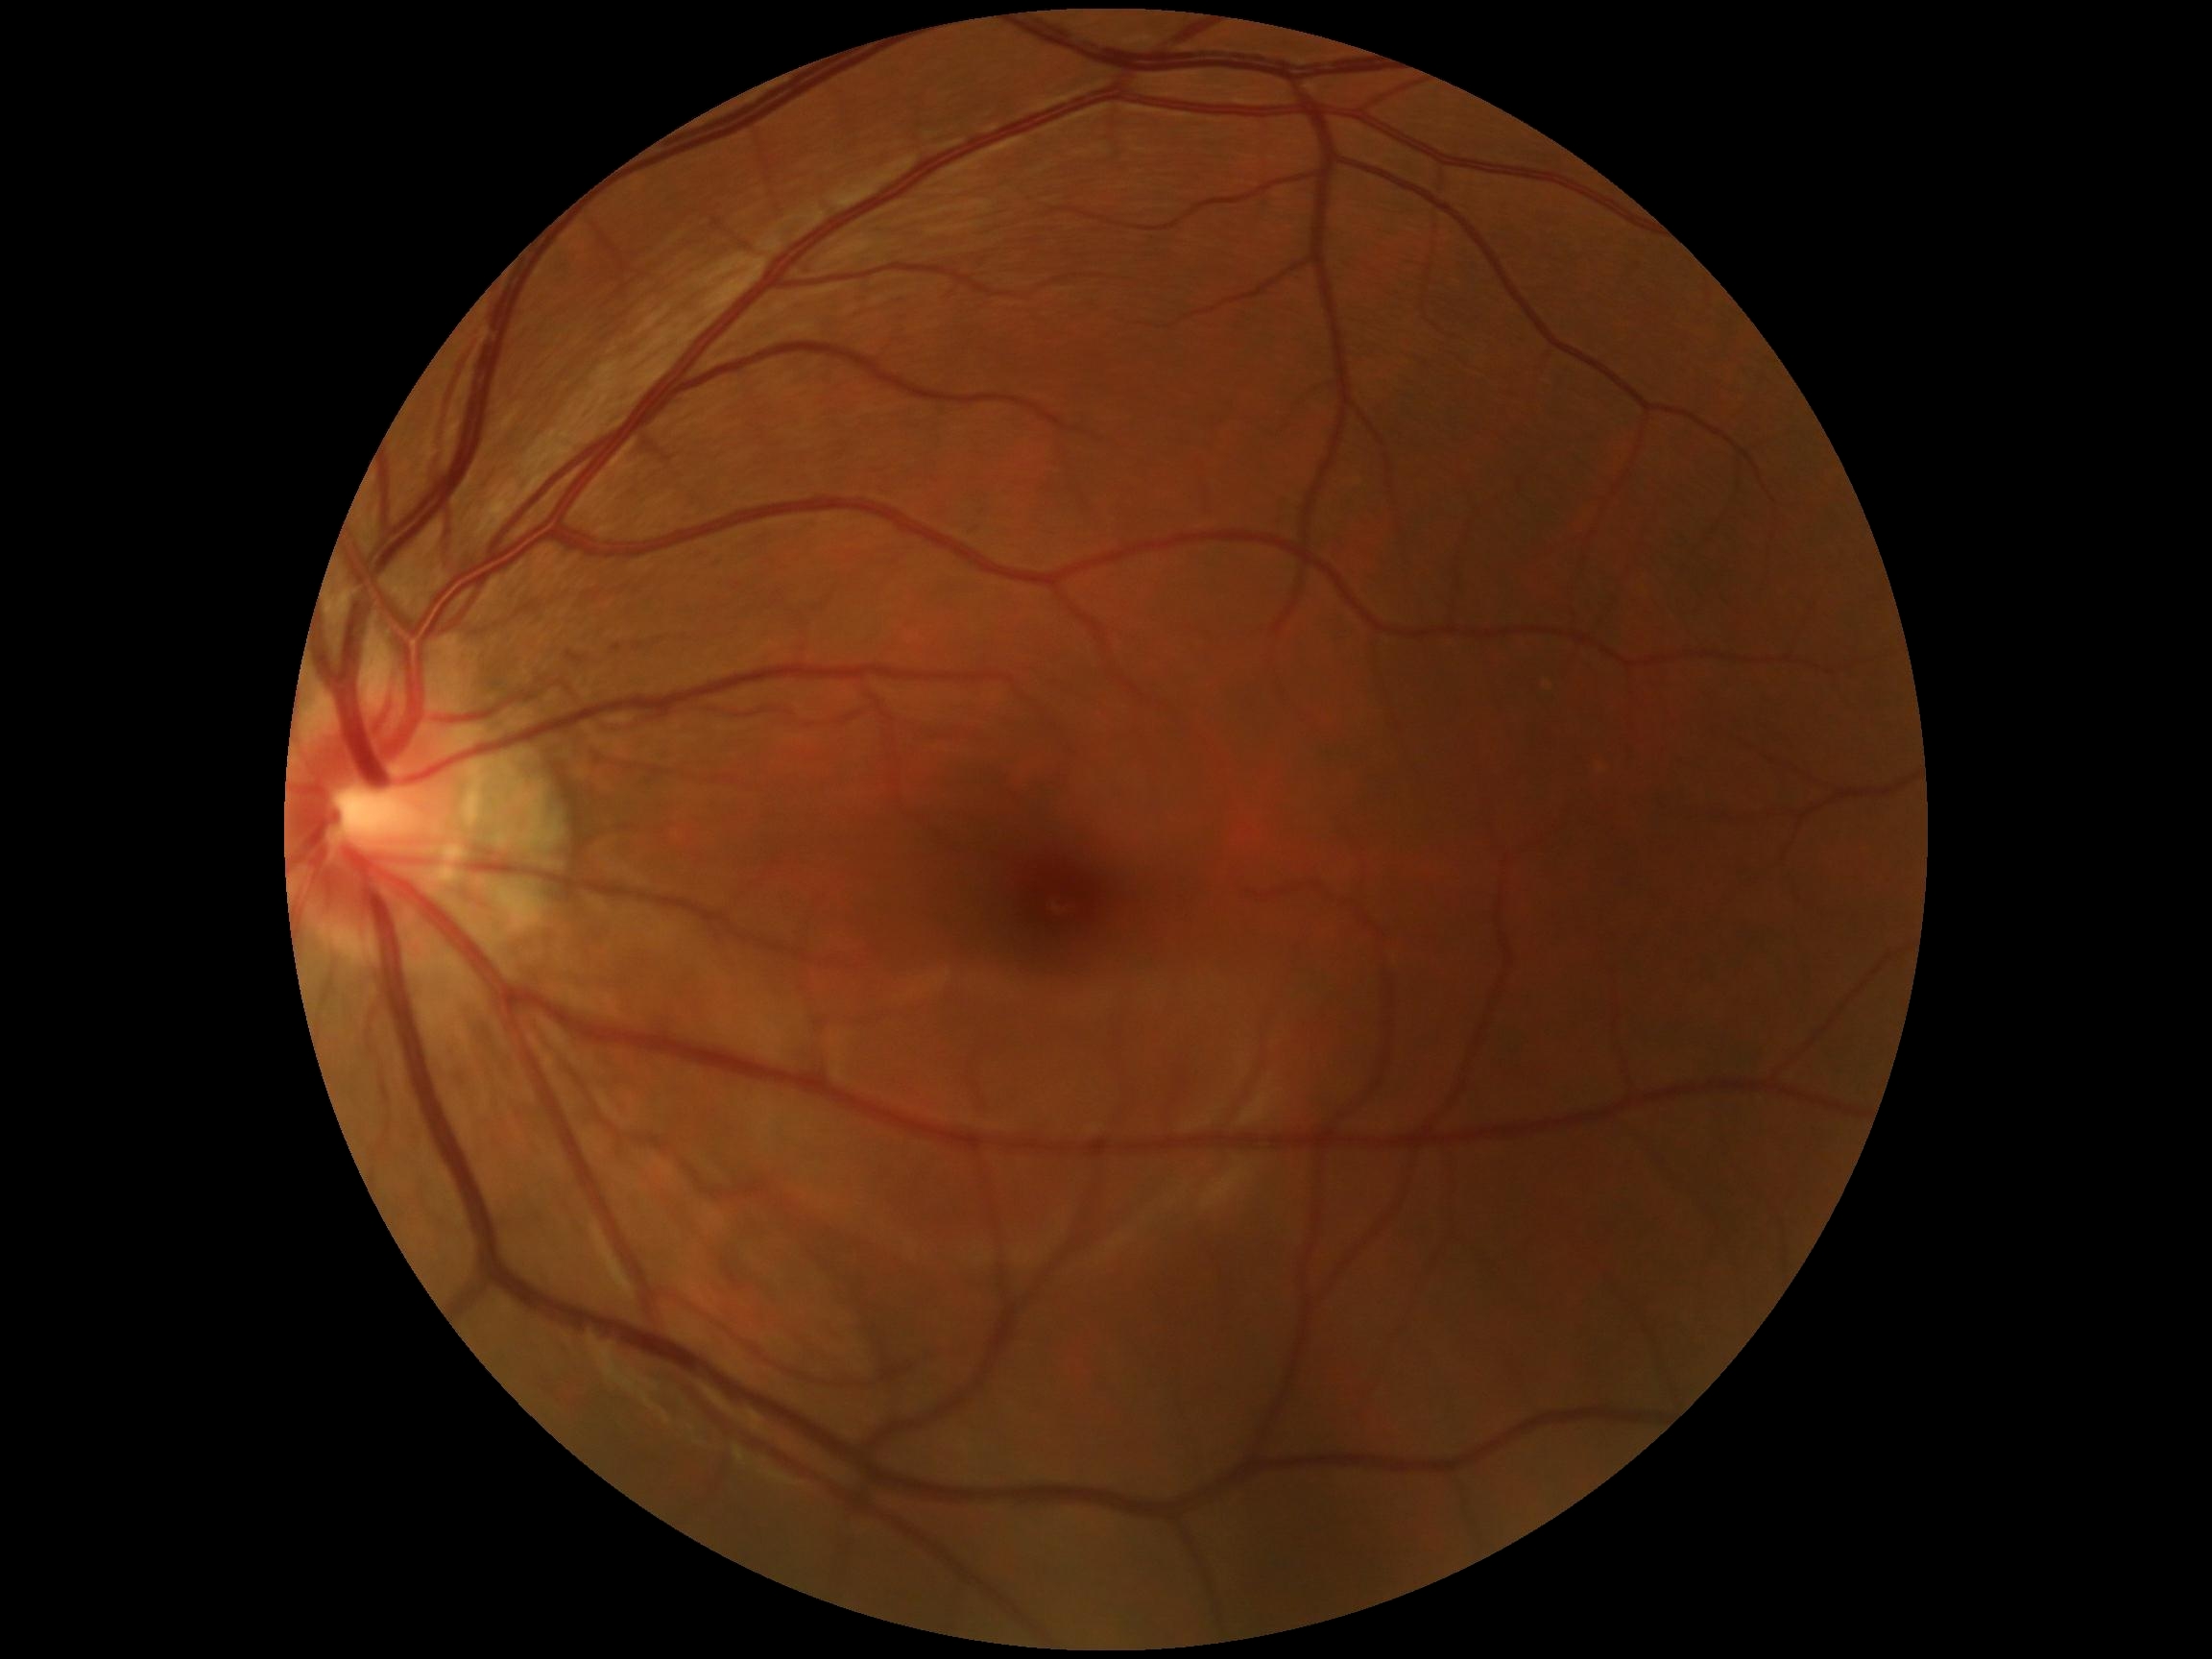 DR: 0.